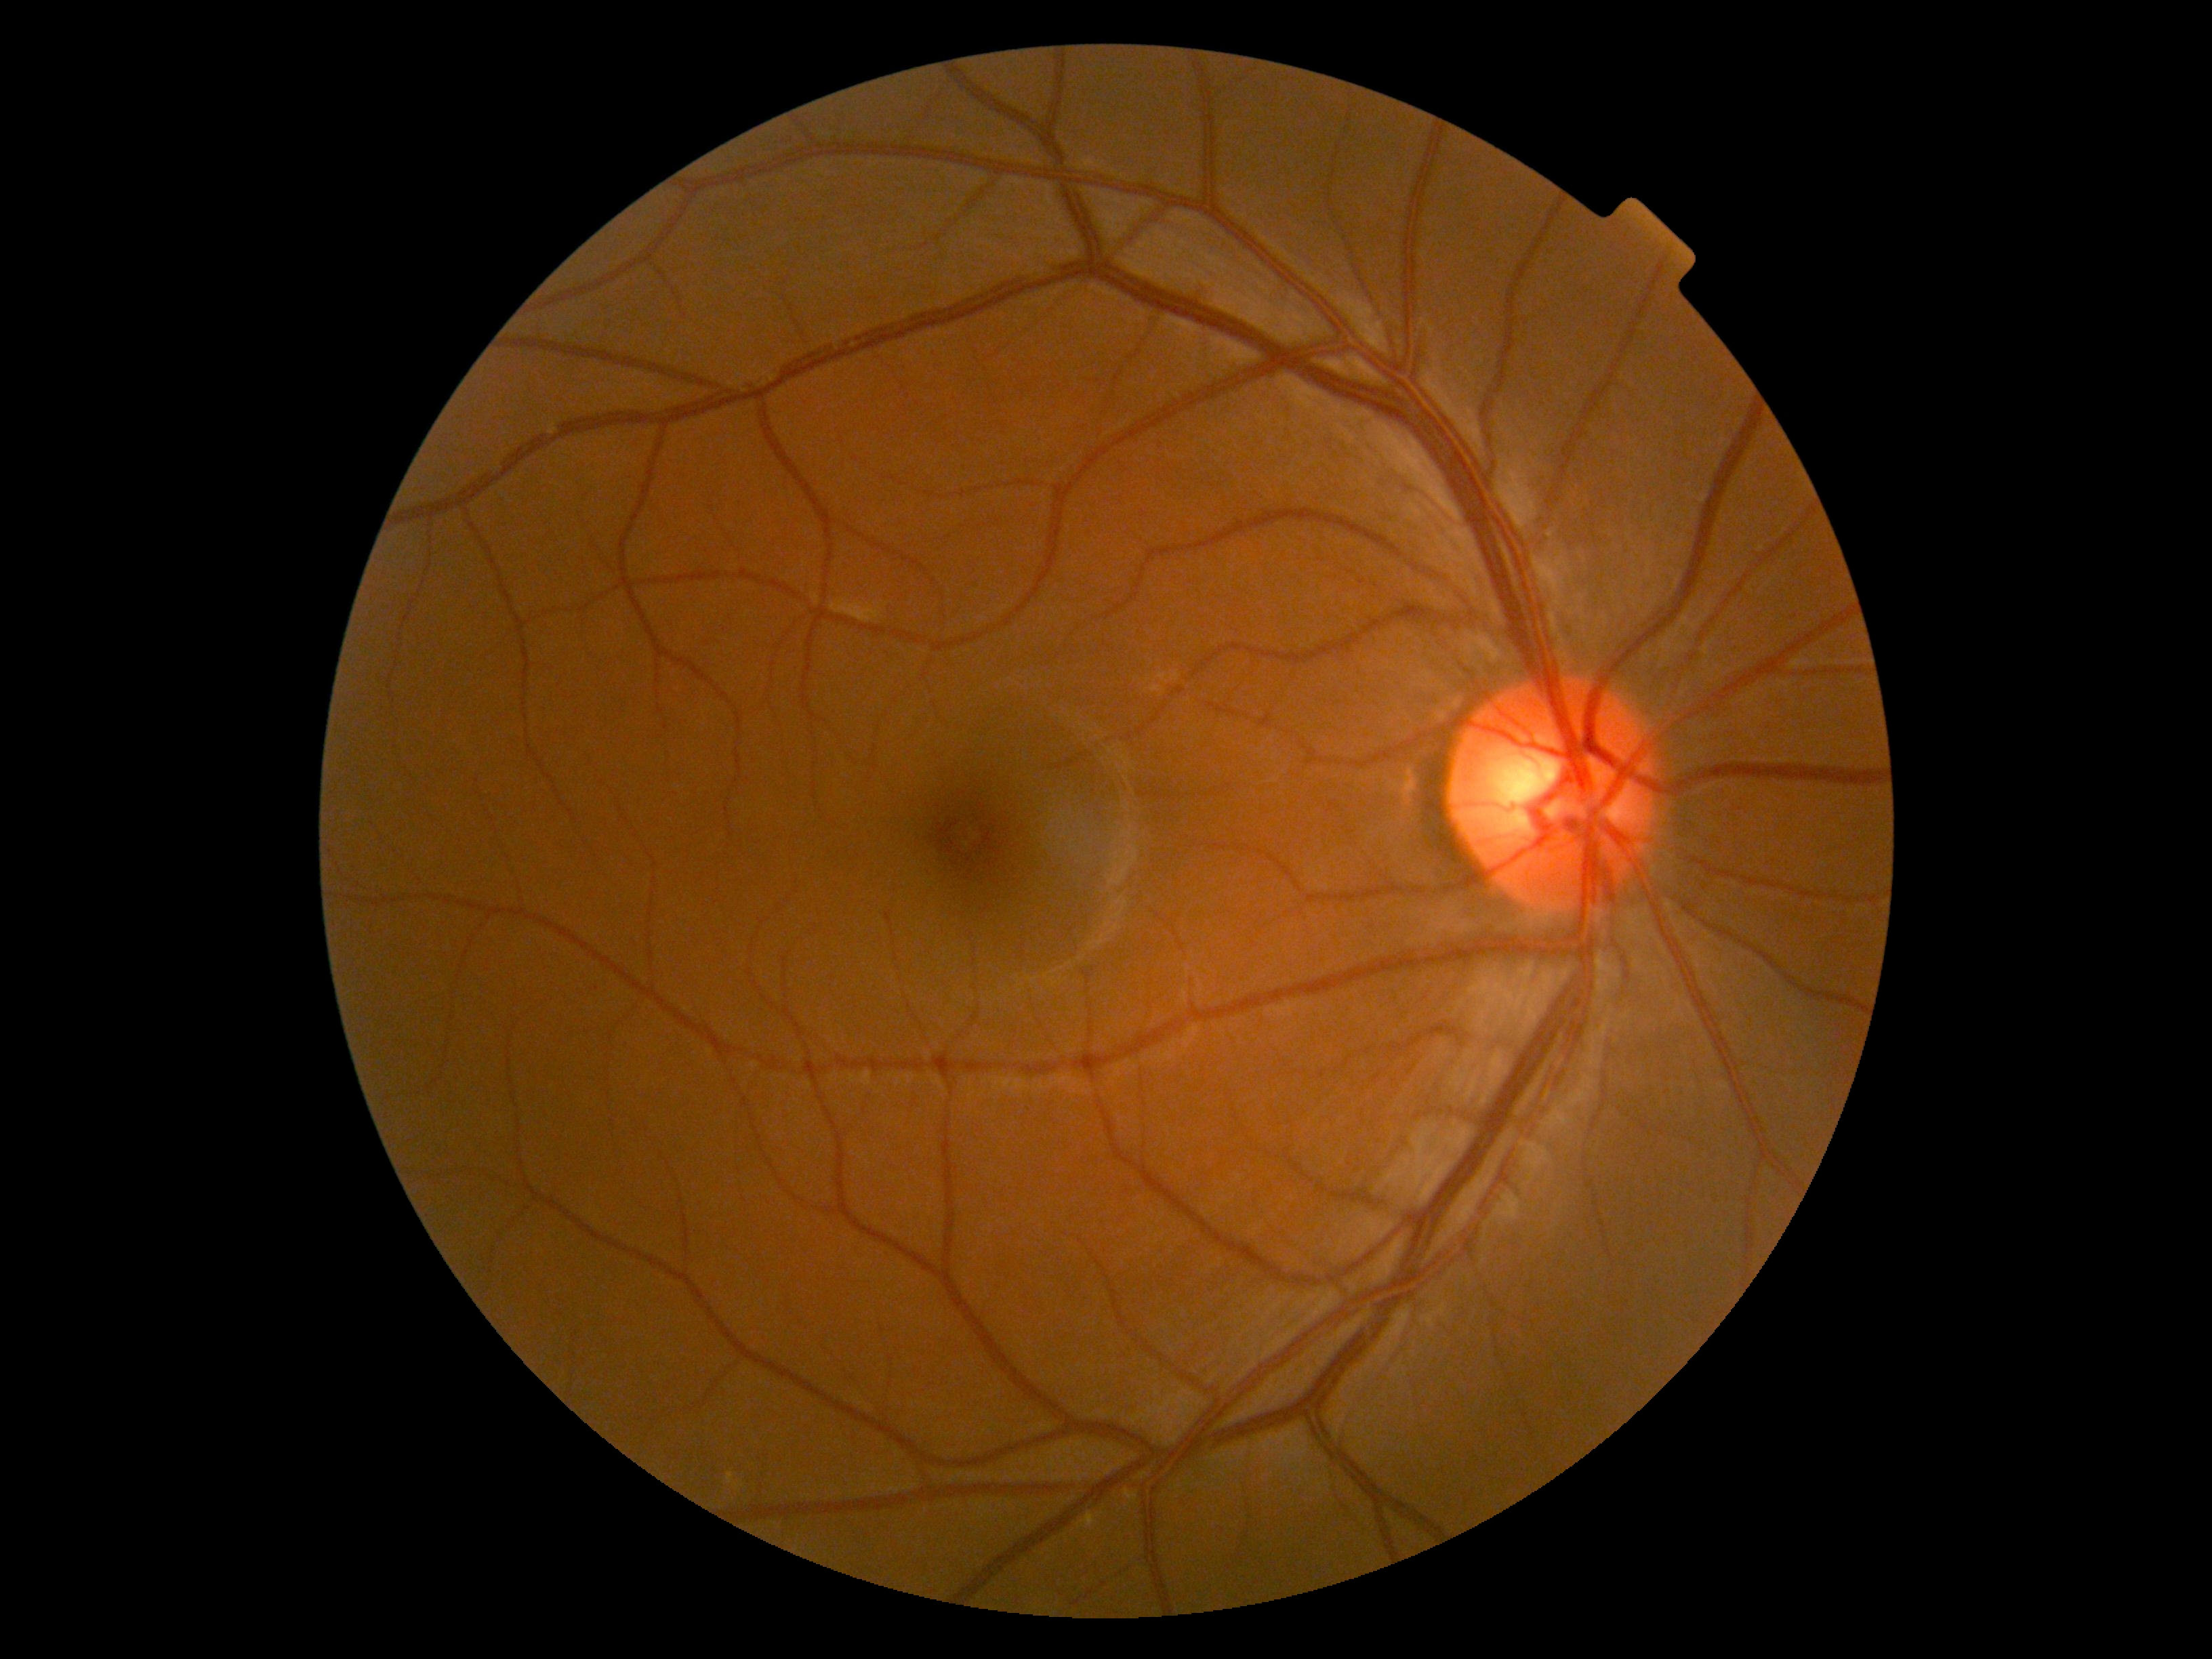

DR severity is 0/4.